45° field of view: 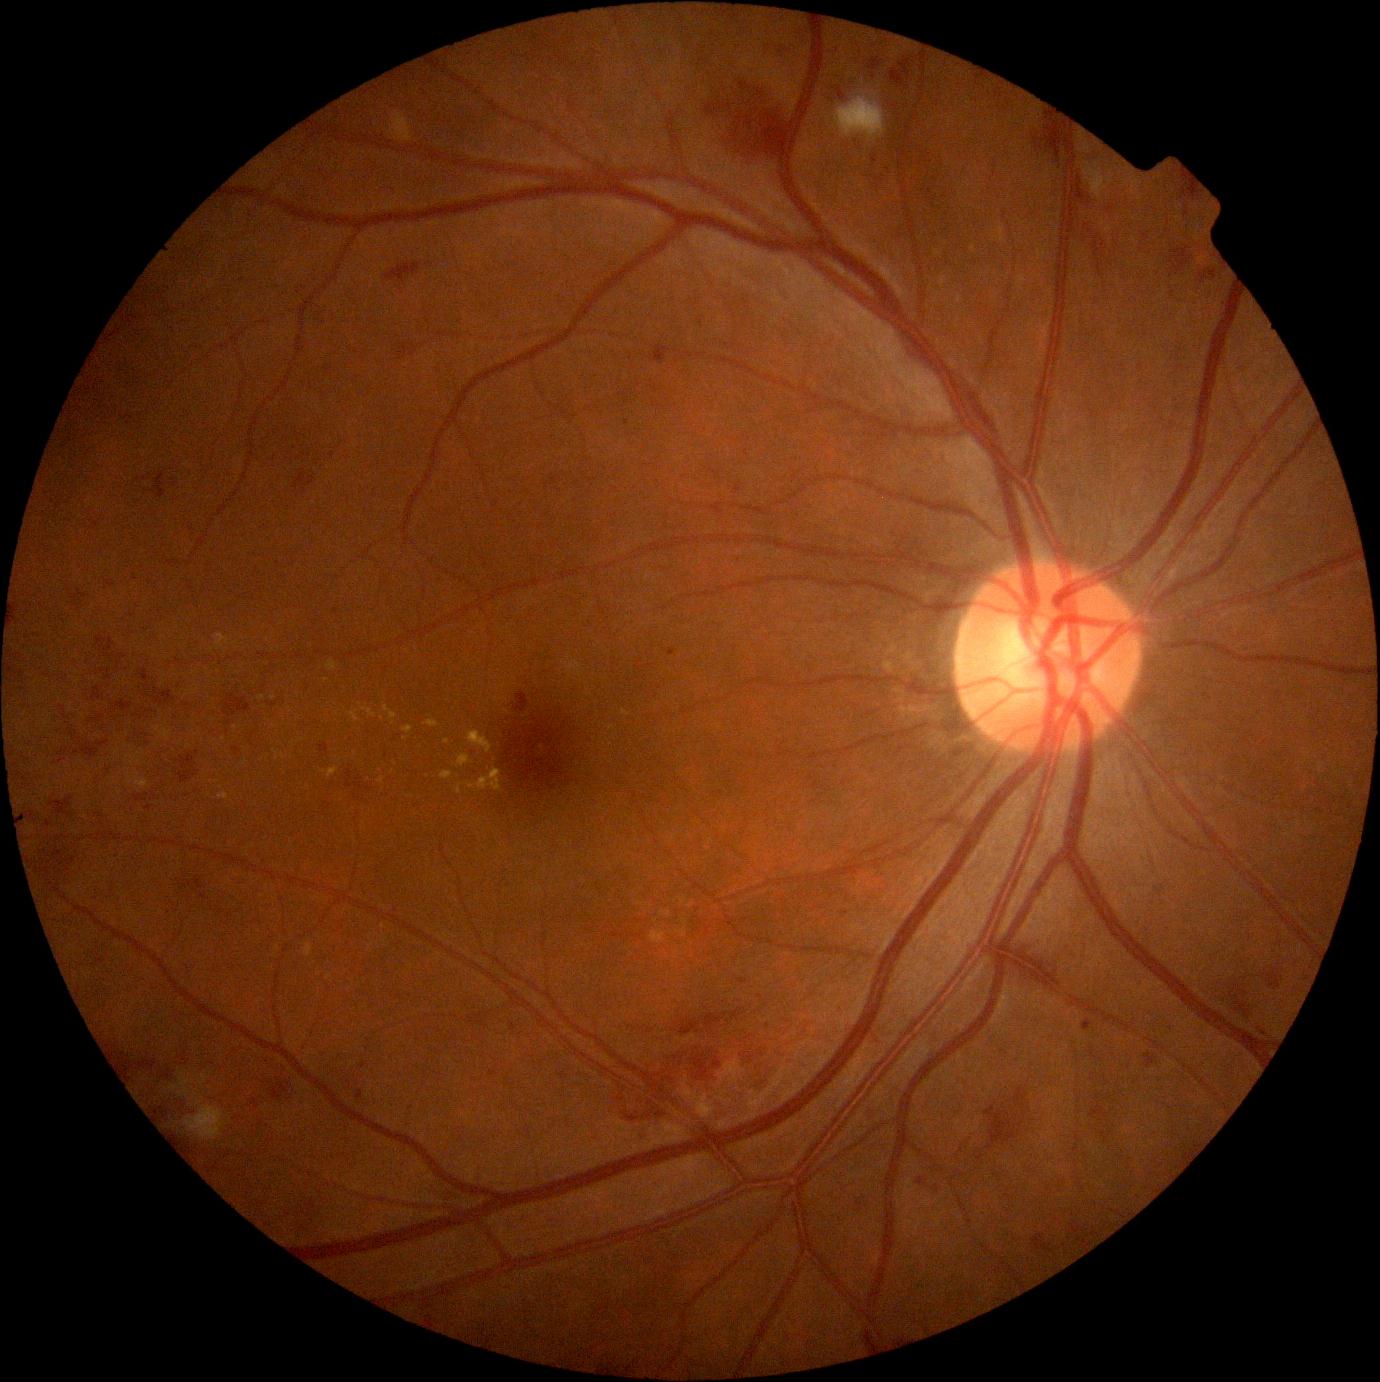

Diabetic retinopathy (DR) is grade 2 — more than just microaneurysms but less than severe NPDR. DR class: non-proliferative diabetic retinopathy.